Wide-field contact fundus photograph of an infant:
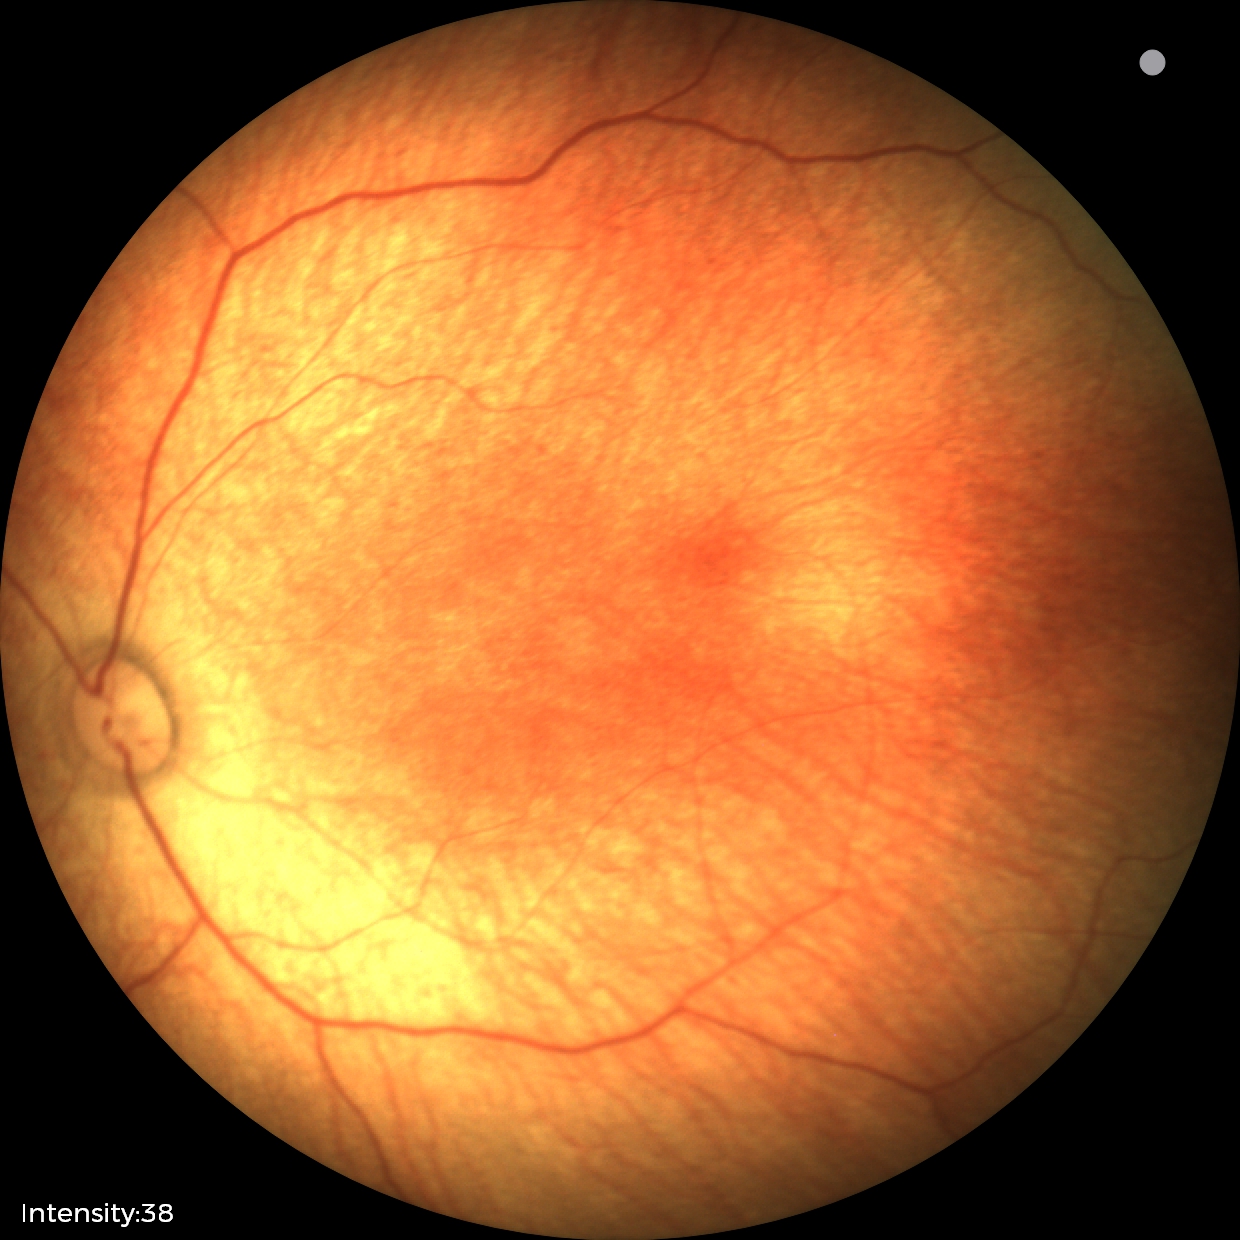 Screening examination with no abnormal retinal findings.